Camera: NIDEK AFC-230: 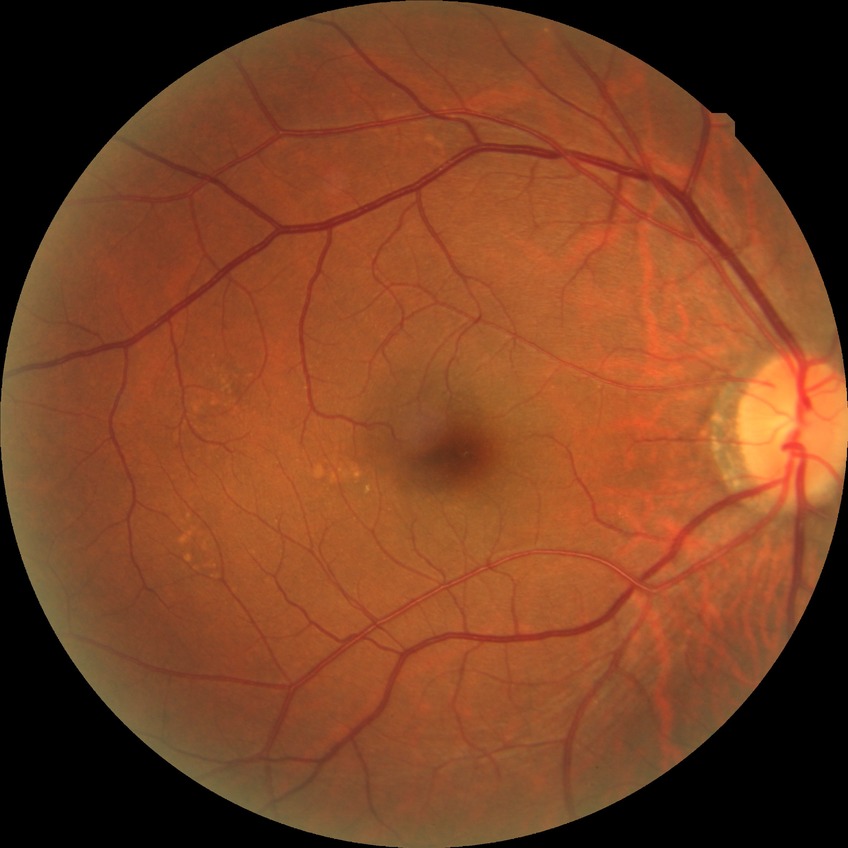
No apparent diabetic retinopathy.
DR severity: NDR.